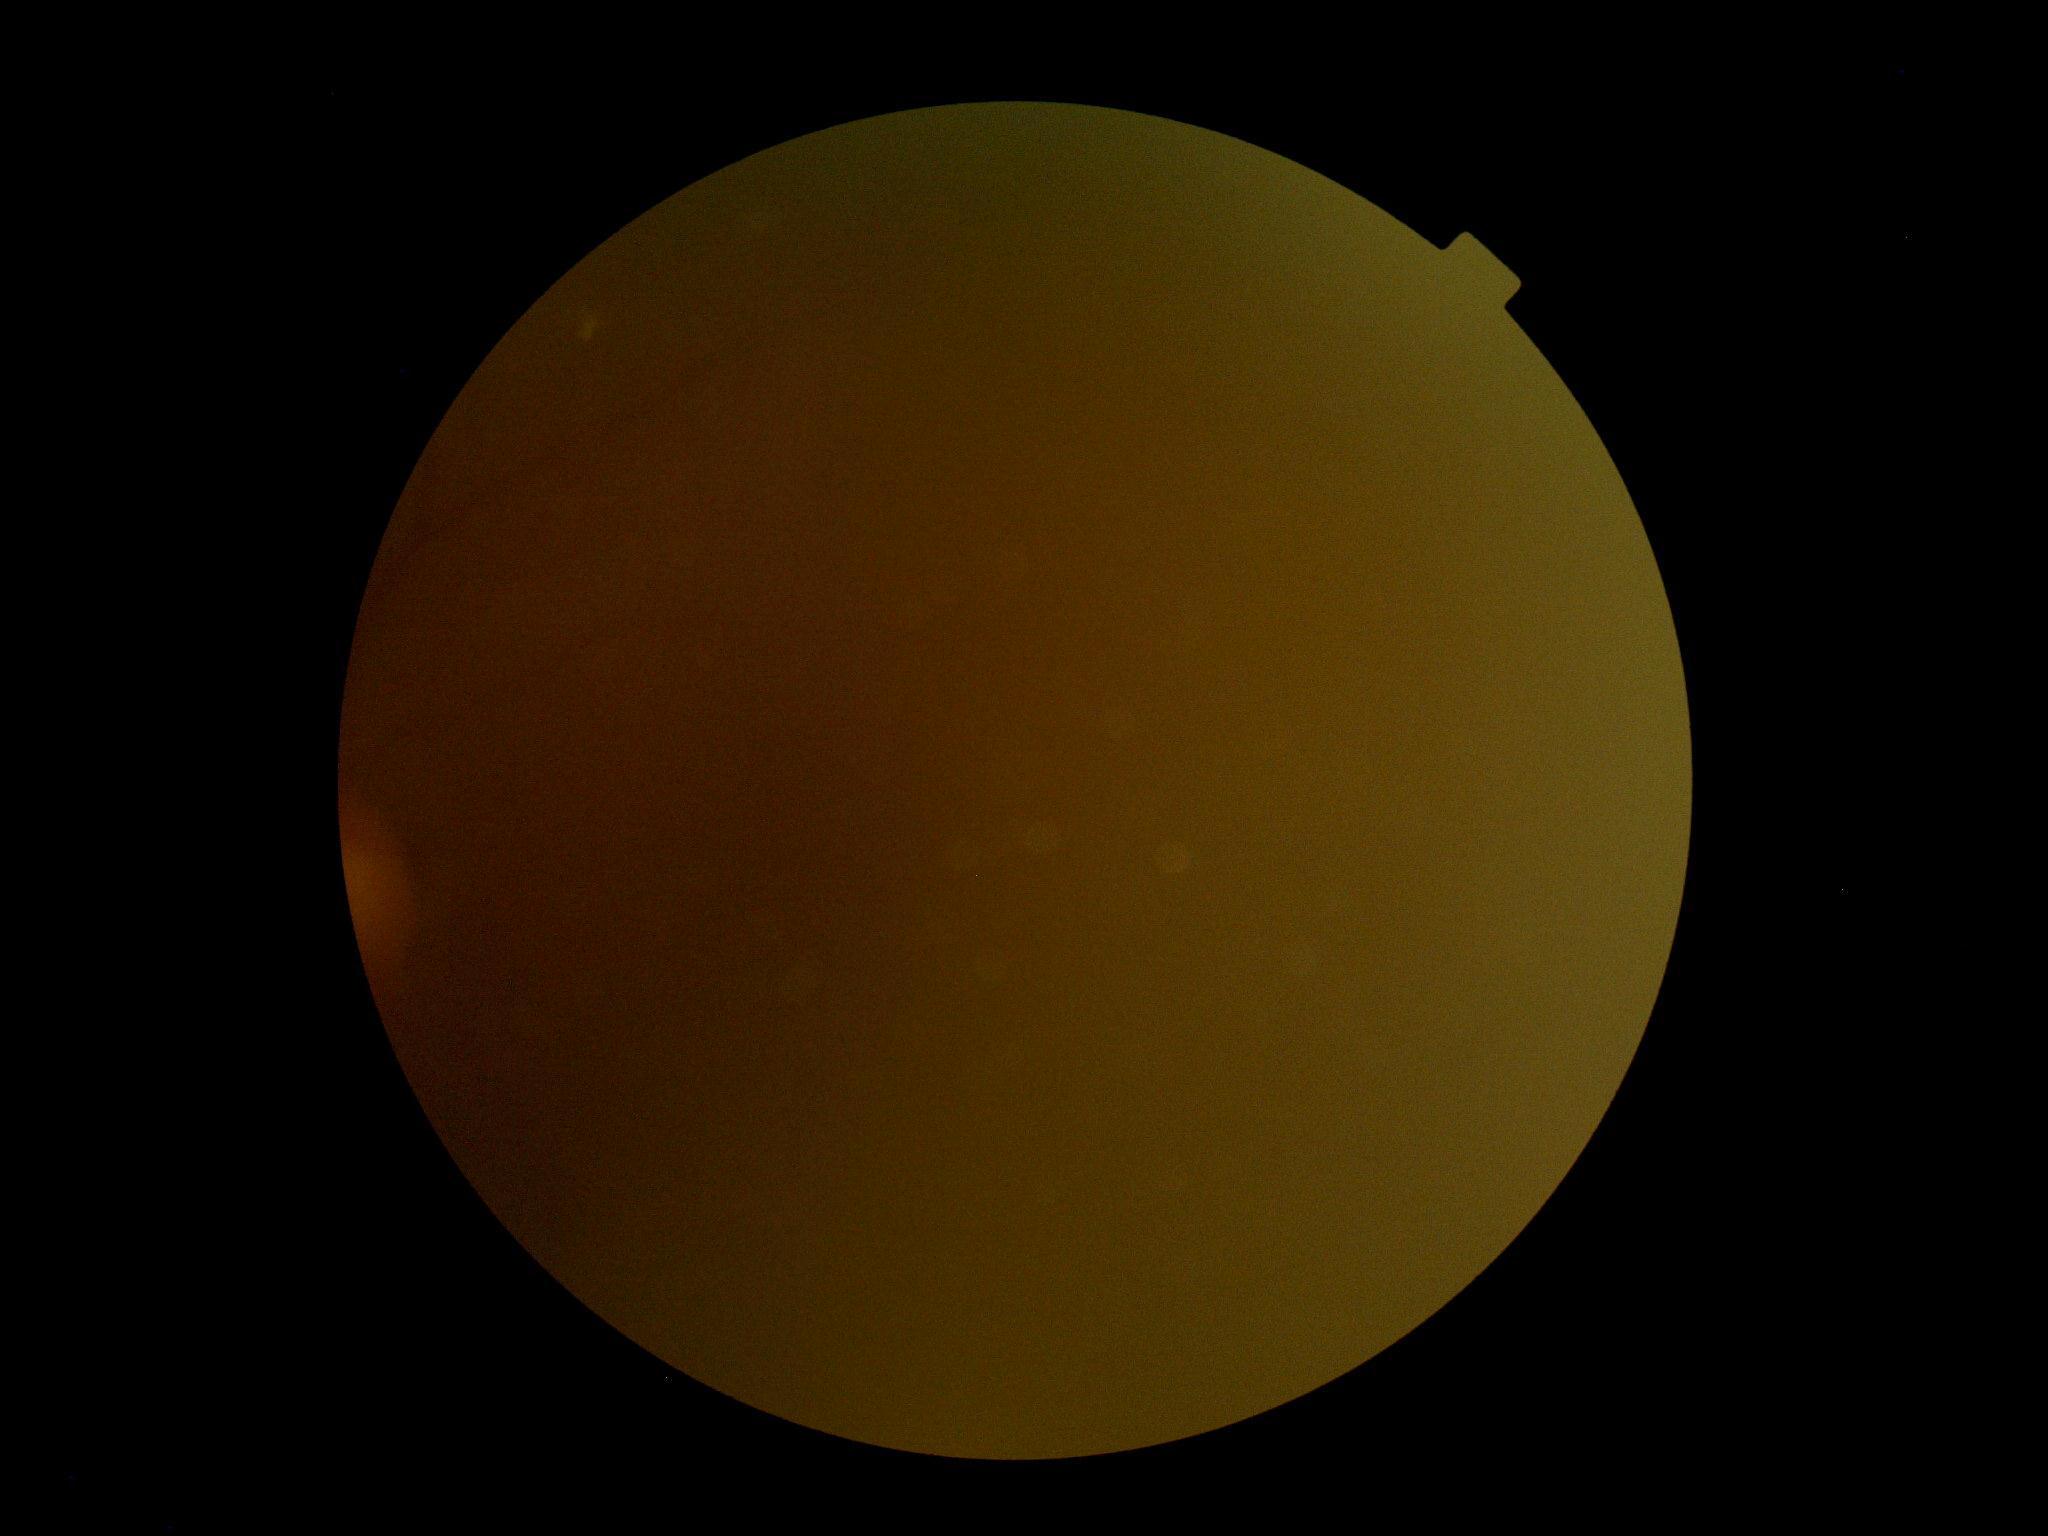

DR severity: ungradable. Ungradable image — DR severity cannot be determined.